Wide-field fundus image from infant ROP screening.
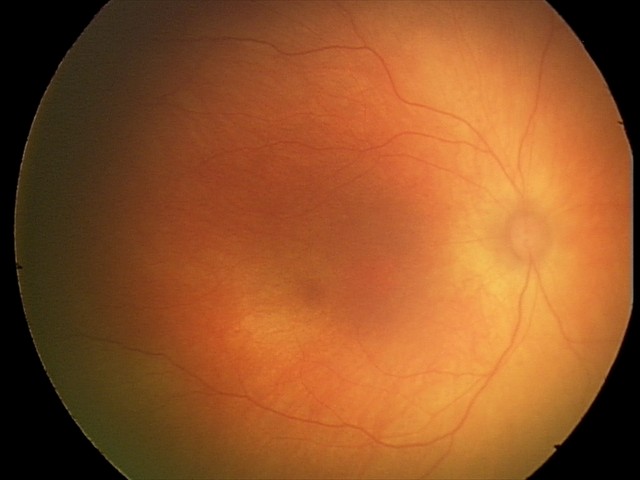 Impression: normal fundus examination.